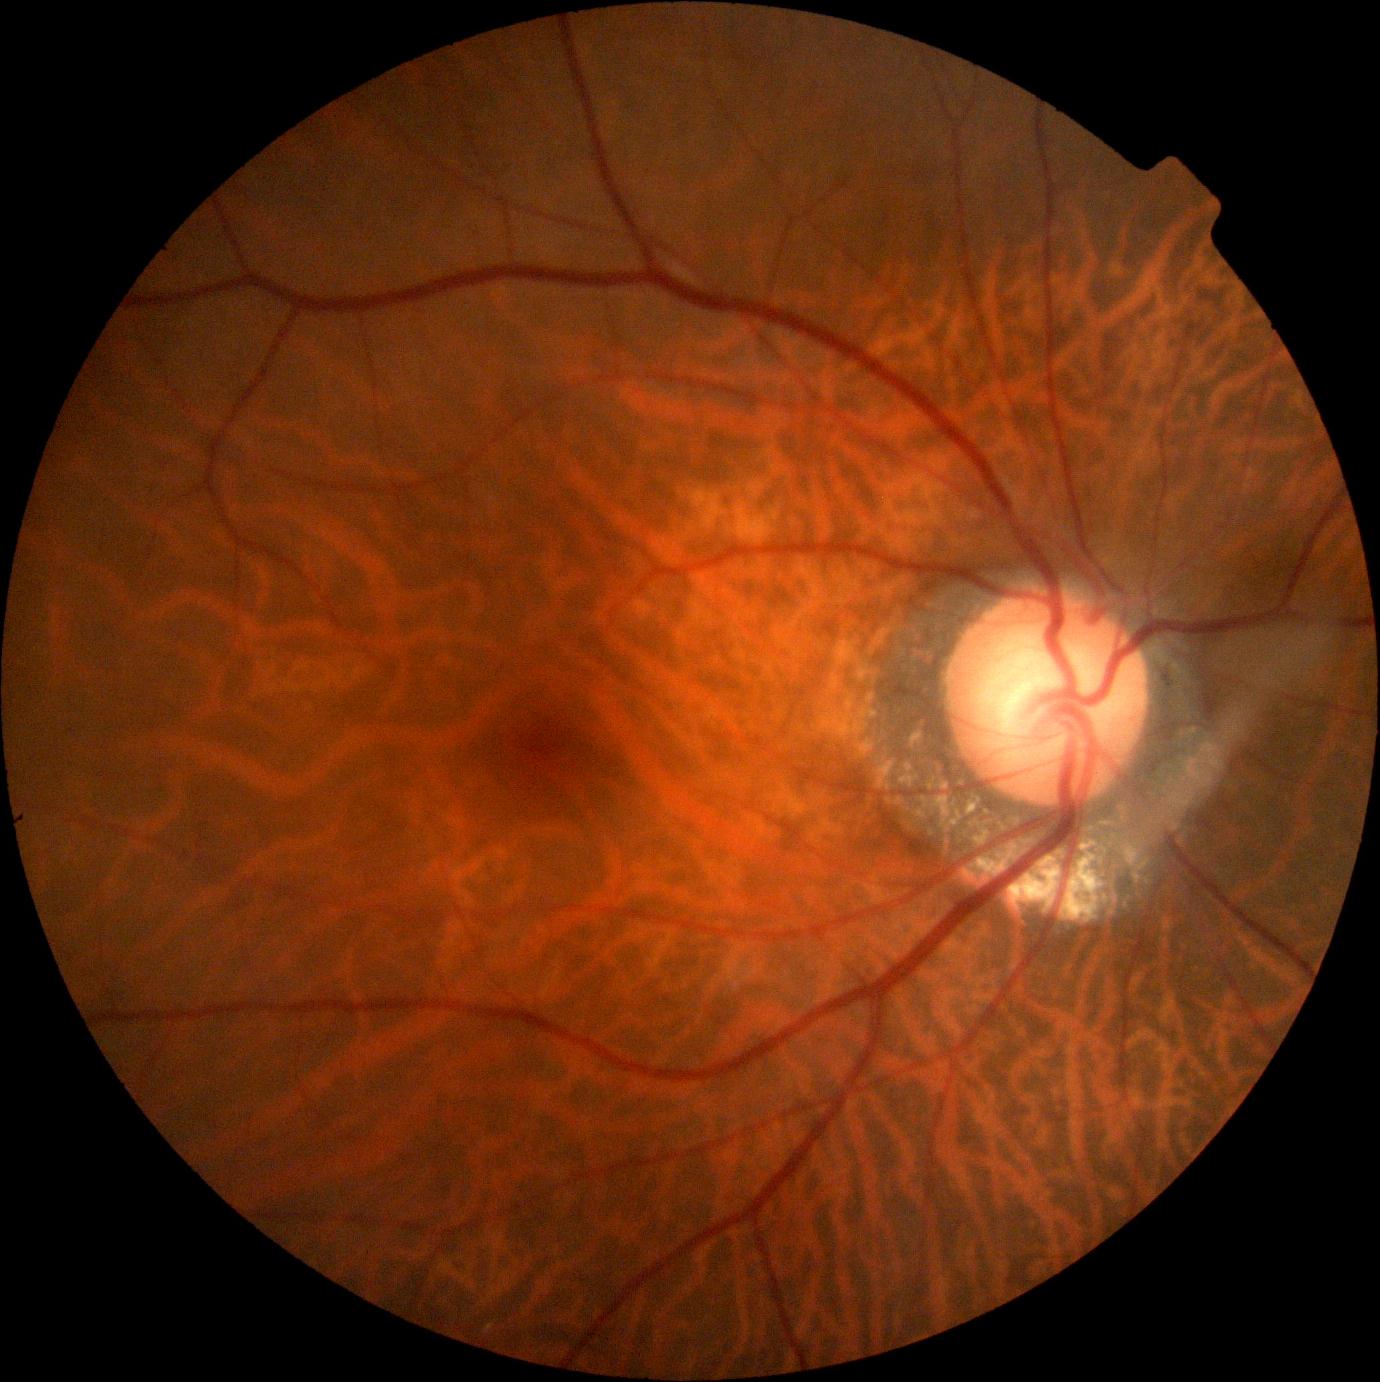

DR severity = grade 0 (no apparent retinopathy).